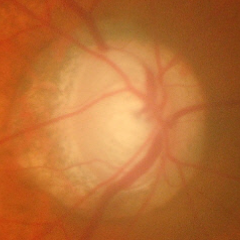
Findings consistent with glaucoma. Glaucoma assessment = advanced glaucomatous optic neuropathy.